Acquired with a Nidek AFC-330
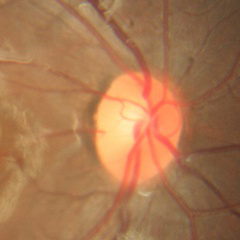

The image shows no signs of glaucoma.